Acquired on the Natus RetCam Envision. Image size 1440x1080. Wide-field fundus photograph from neonatal ROP screening: 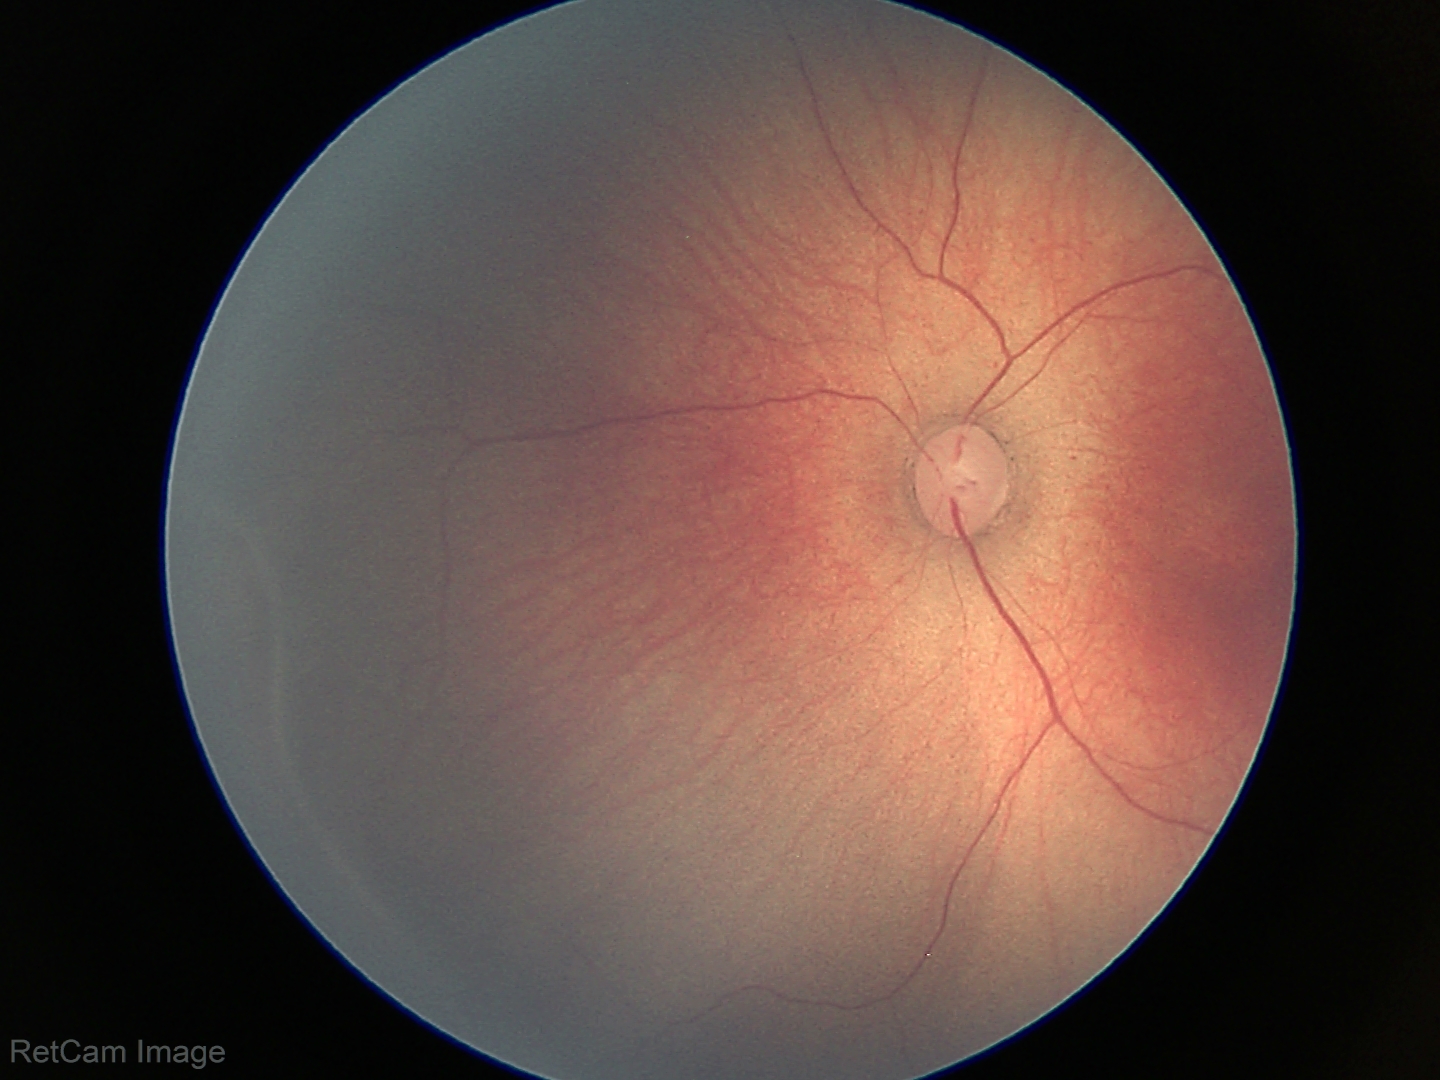

Plus form: absent, assessment: retinopathy of prematurity stage 2.